1240x1240; infant wide-field retinal image.
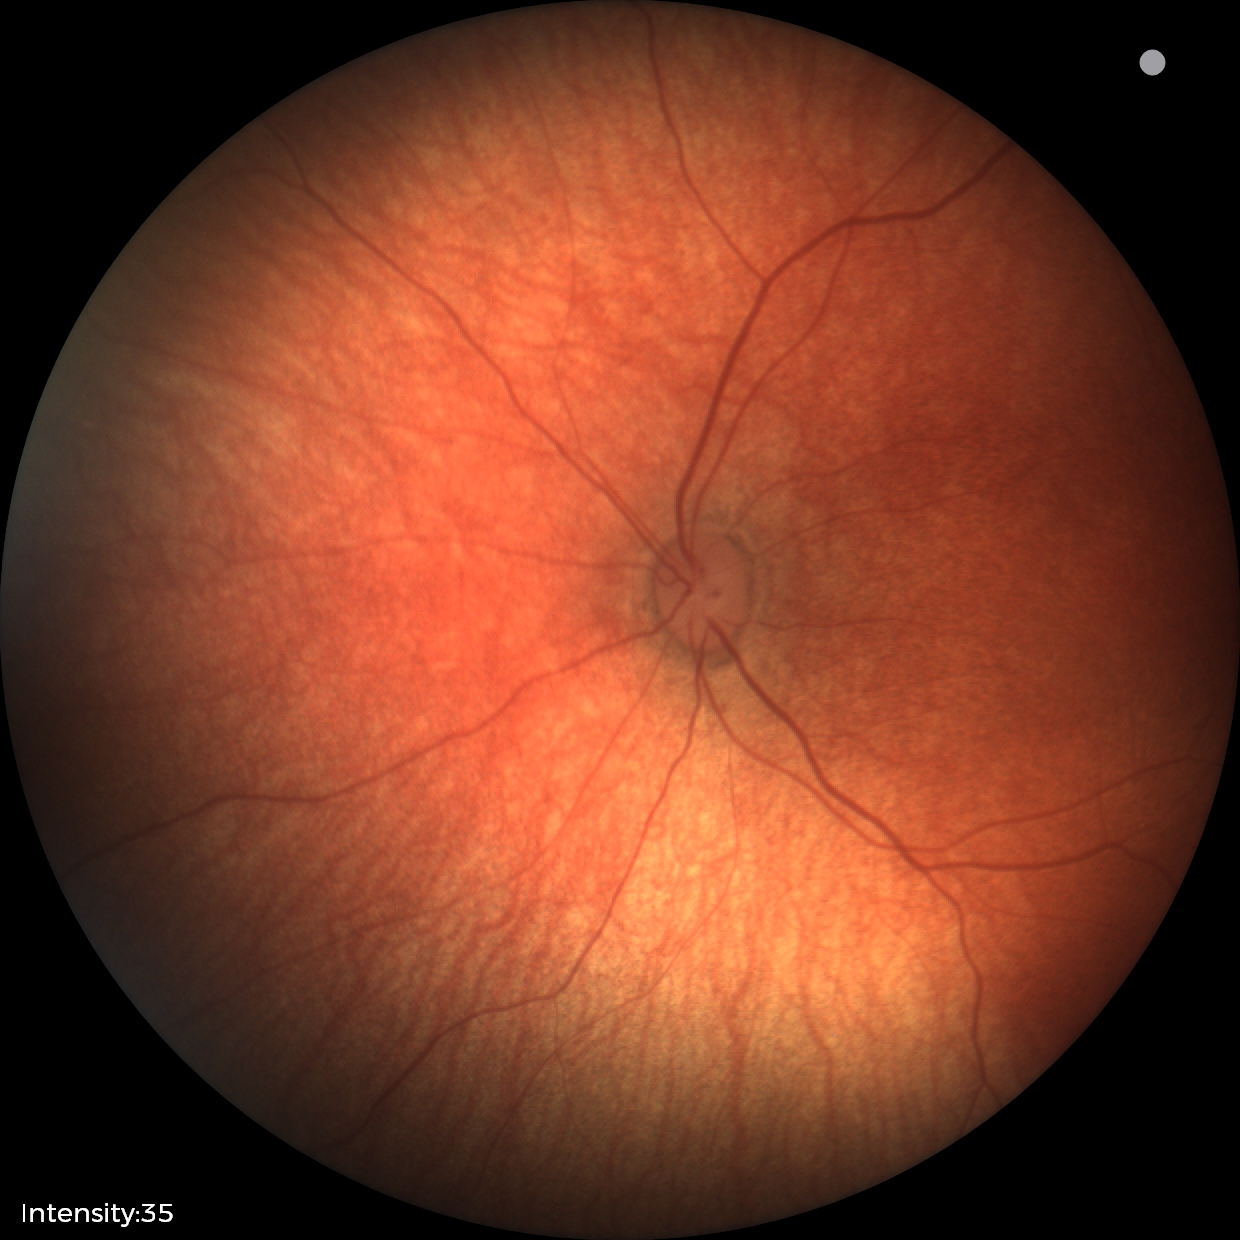

Examination with physiological retinal findings.